Color fundus image — 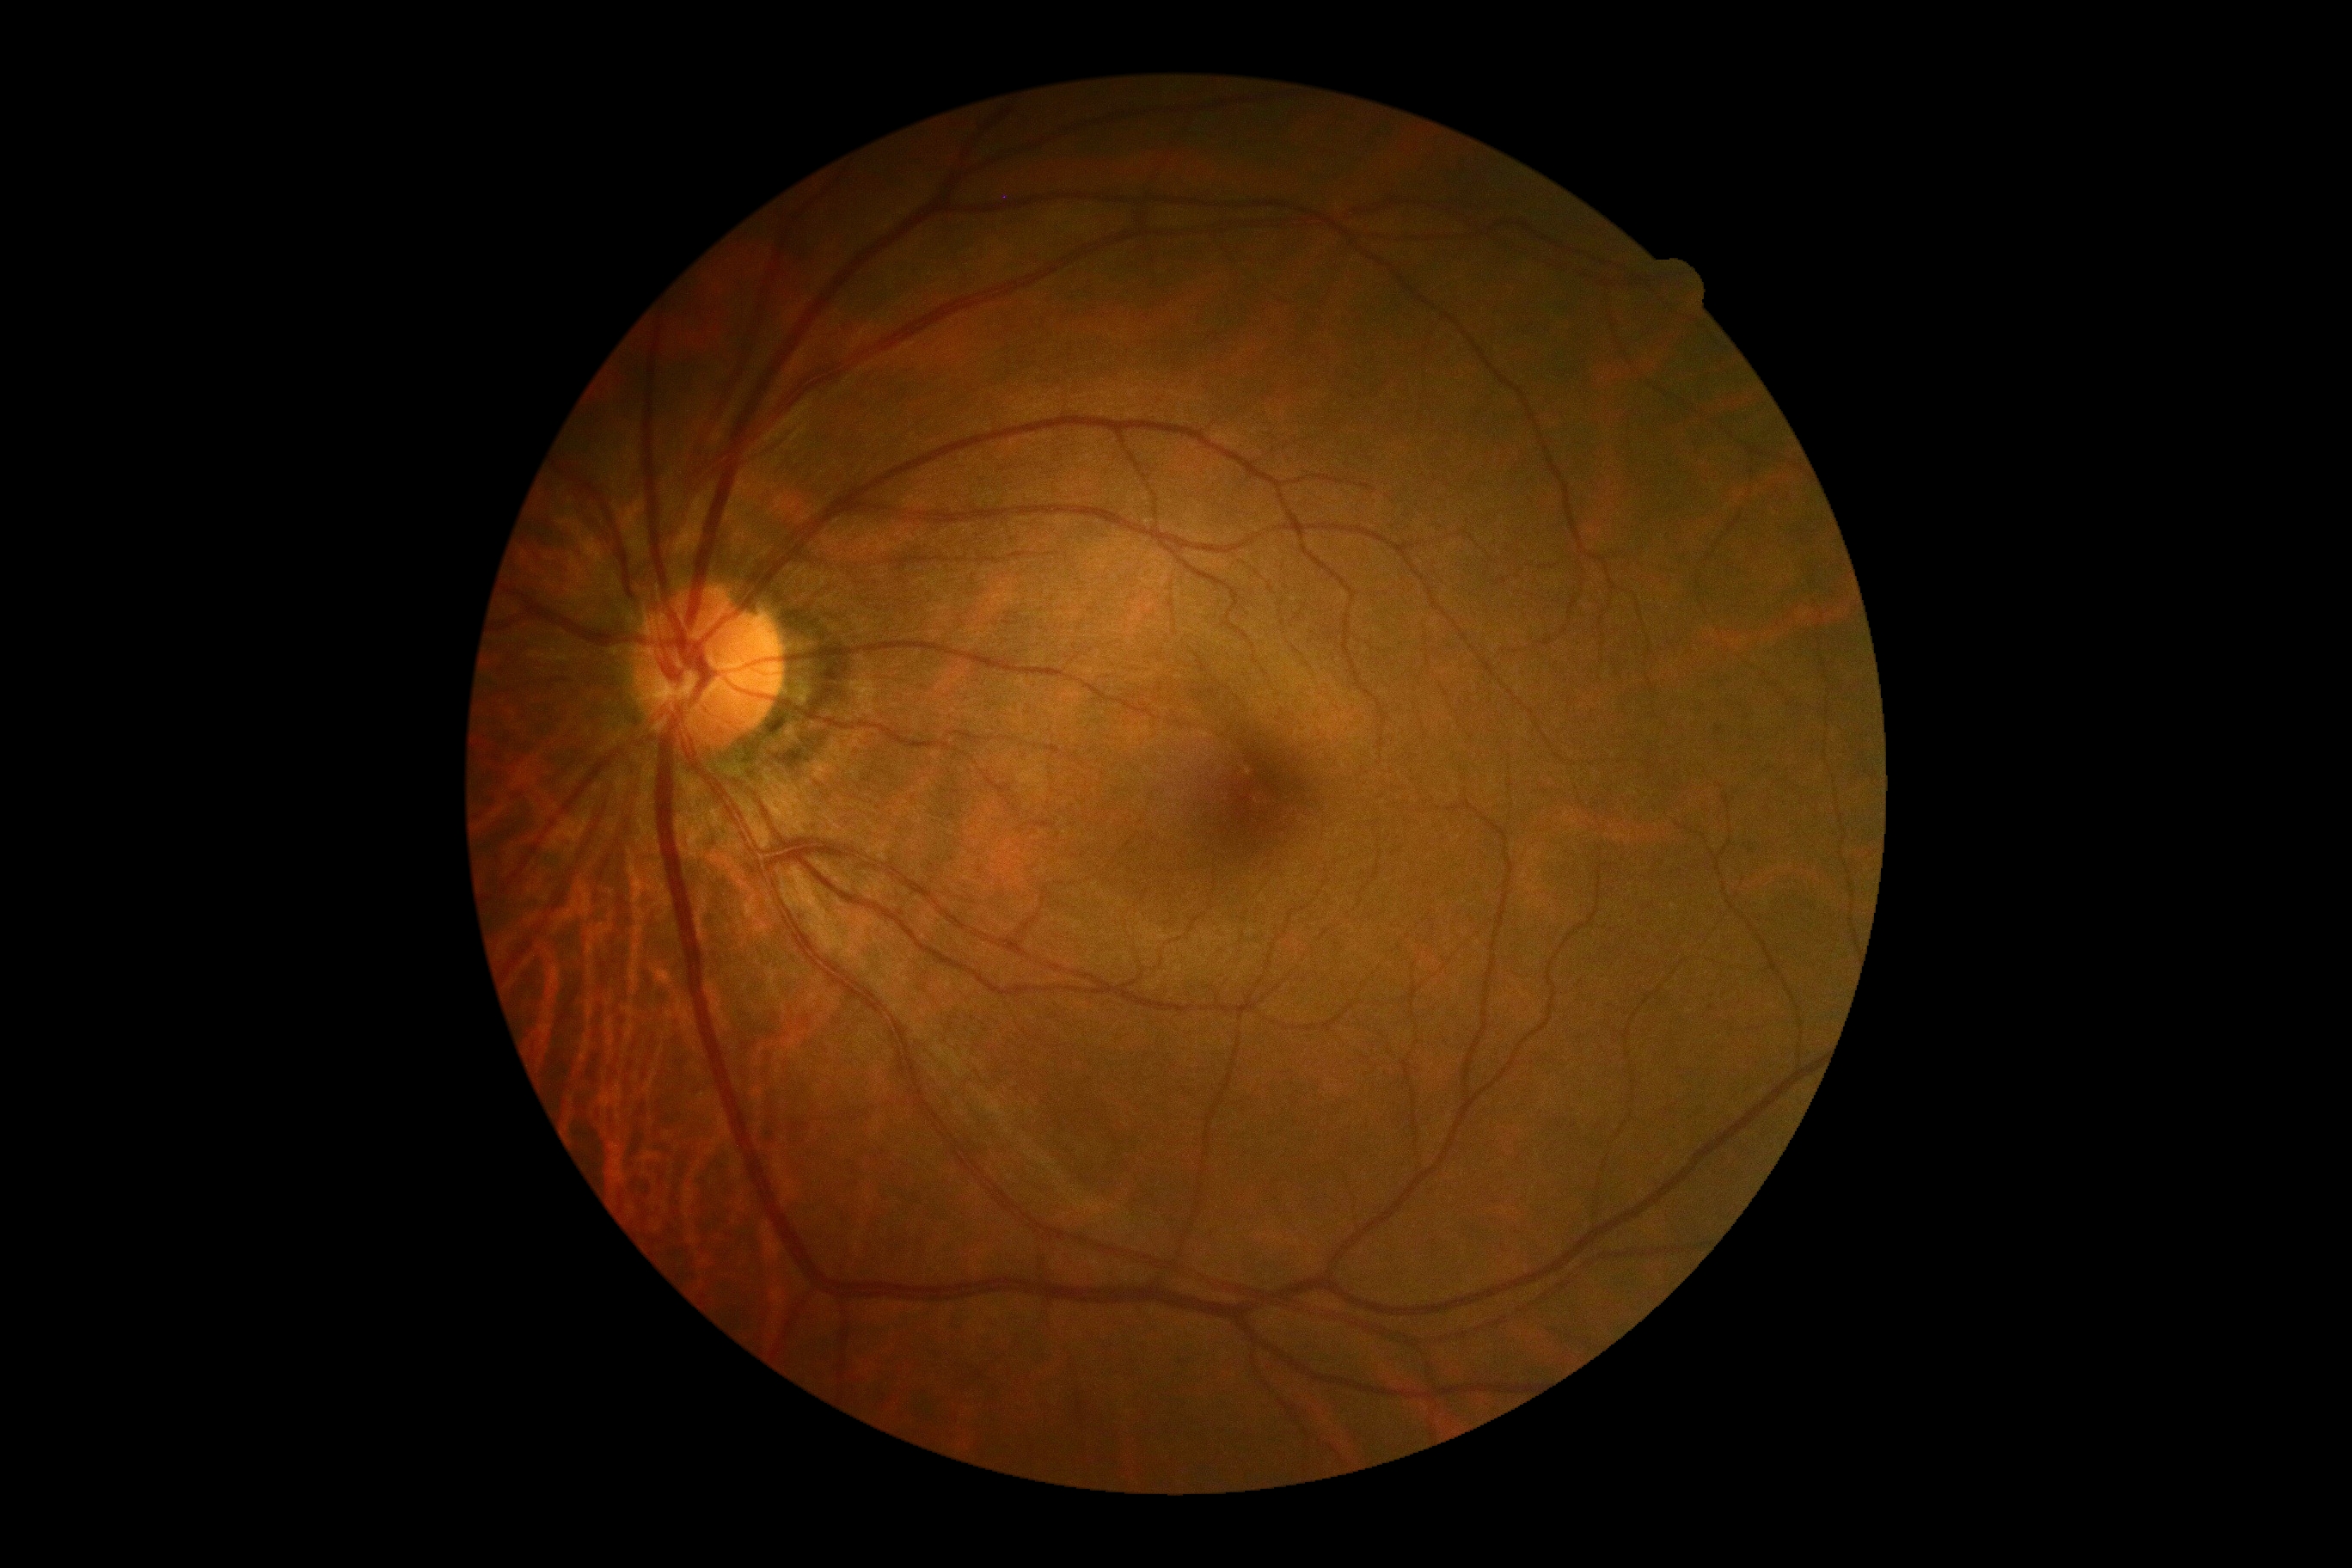 Diabetic retinopathy (DR): no apparent retinopathy (grade 0).